Diabetic retinopathy graded by the modified Davis classification. 848x848 — 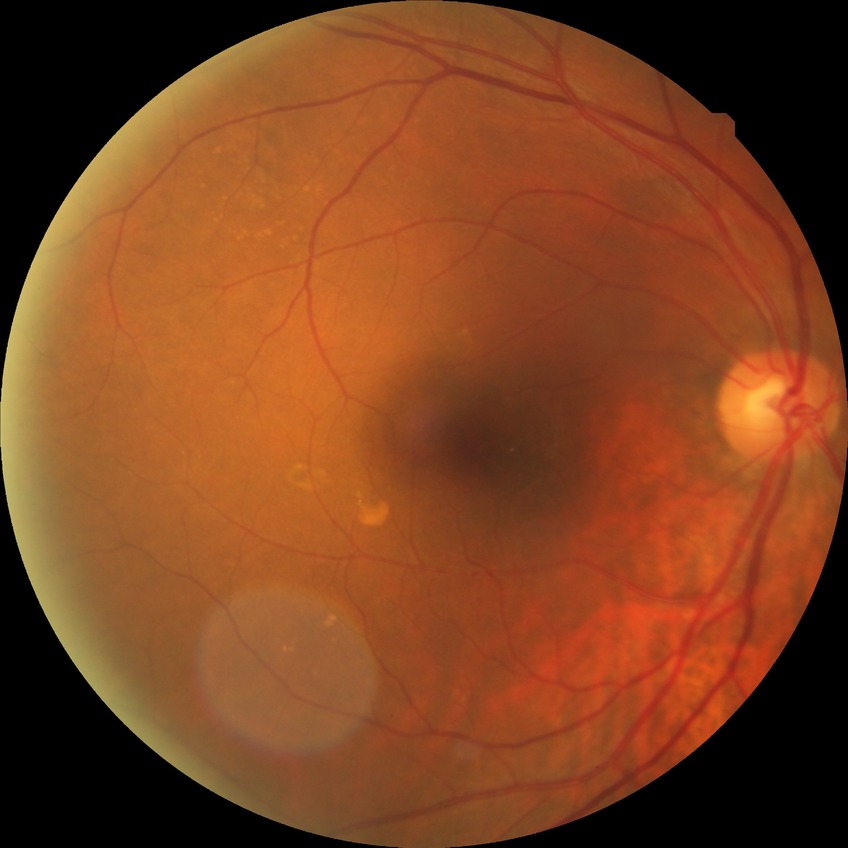 Diabetic retinopathy (DR) is no diabetic retinopathy (NDR).